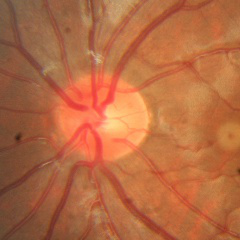 Glaucoma assessment = no glaucoma.